Modified Davis grading; nonmydriatic; 848 x 848 pixels: 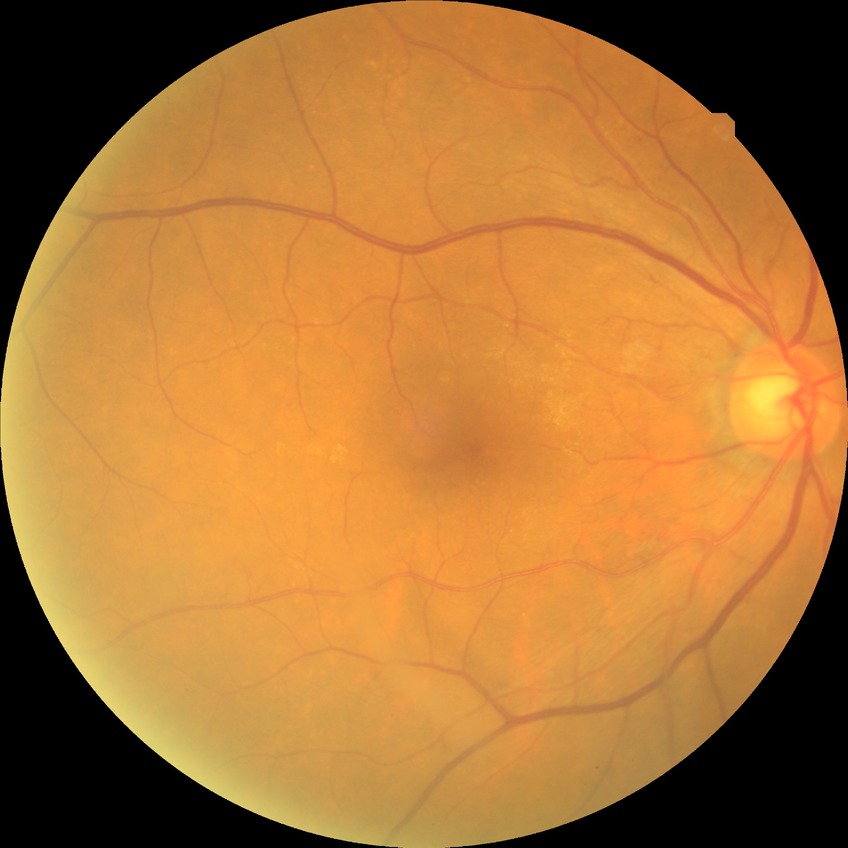
{
  "davis_grade": "no diabetic retinopathy (NDR)"
}